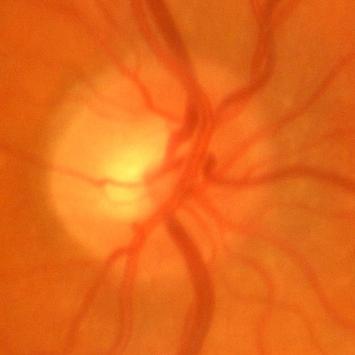 Q: Does this eye have glaucoma?
A: No evidence of glaucoma.